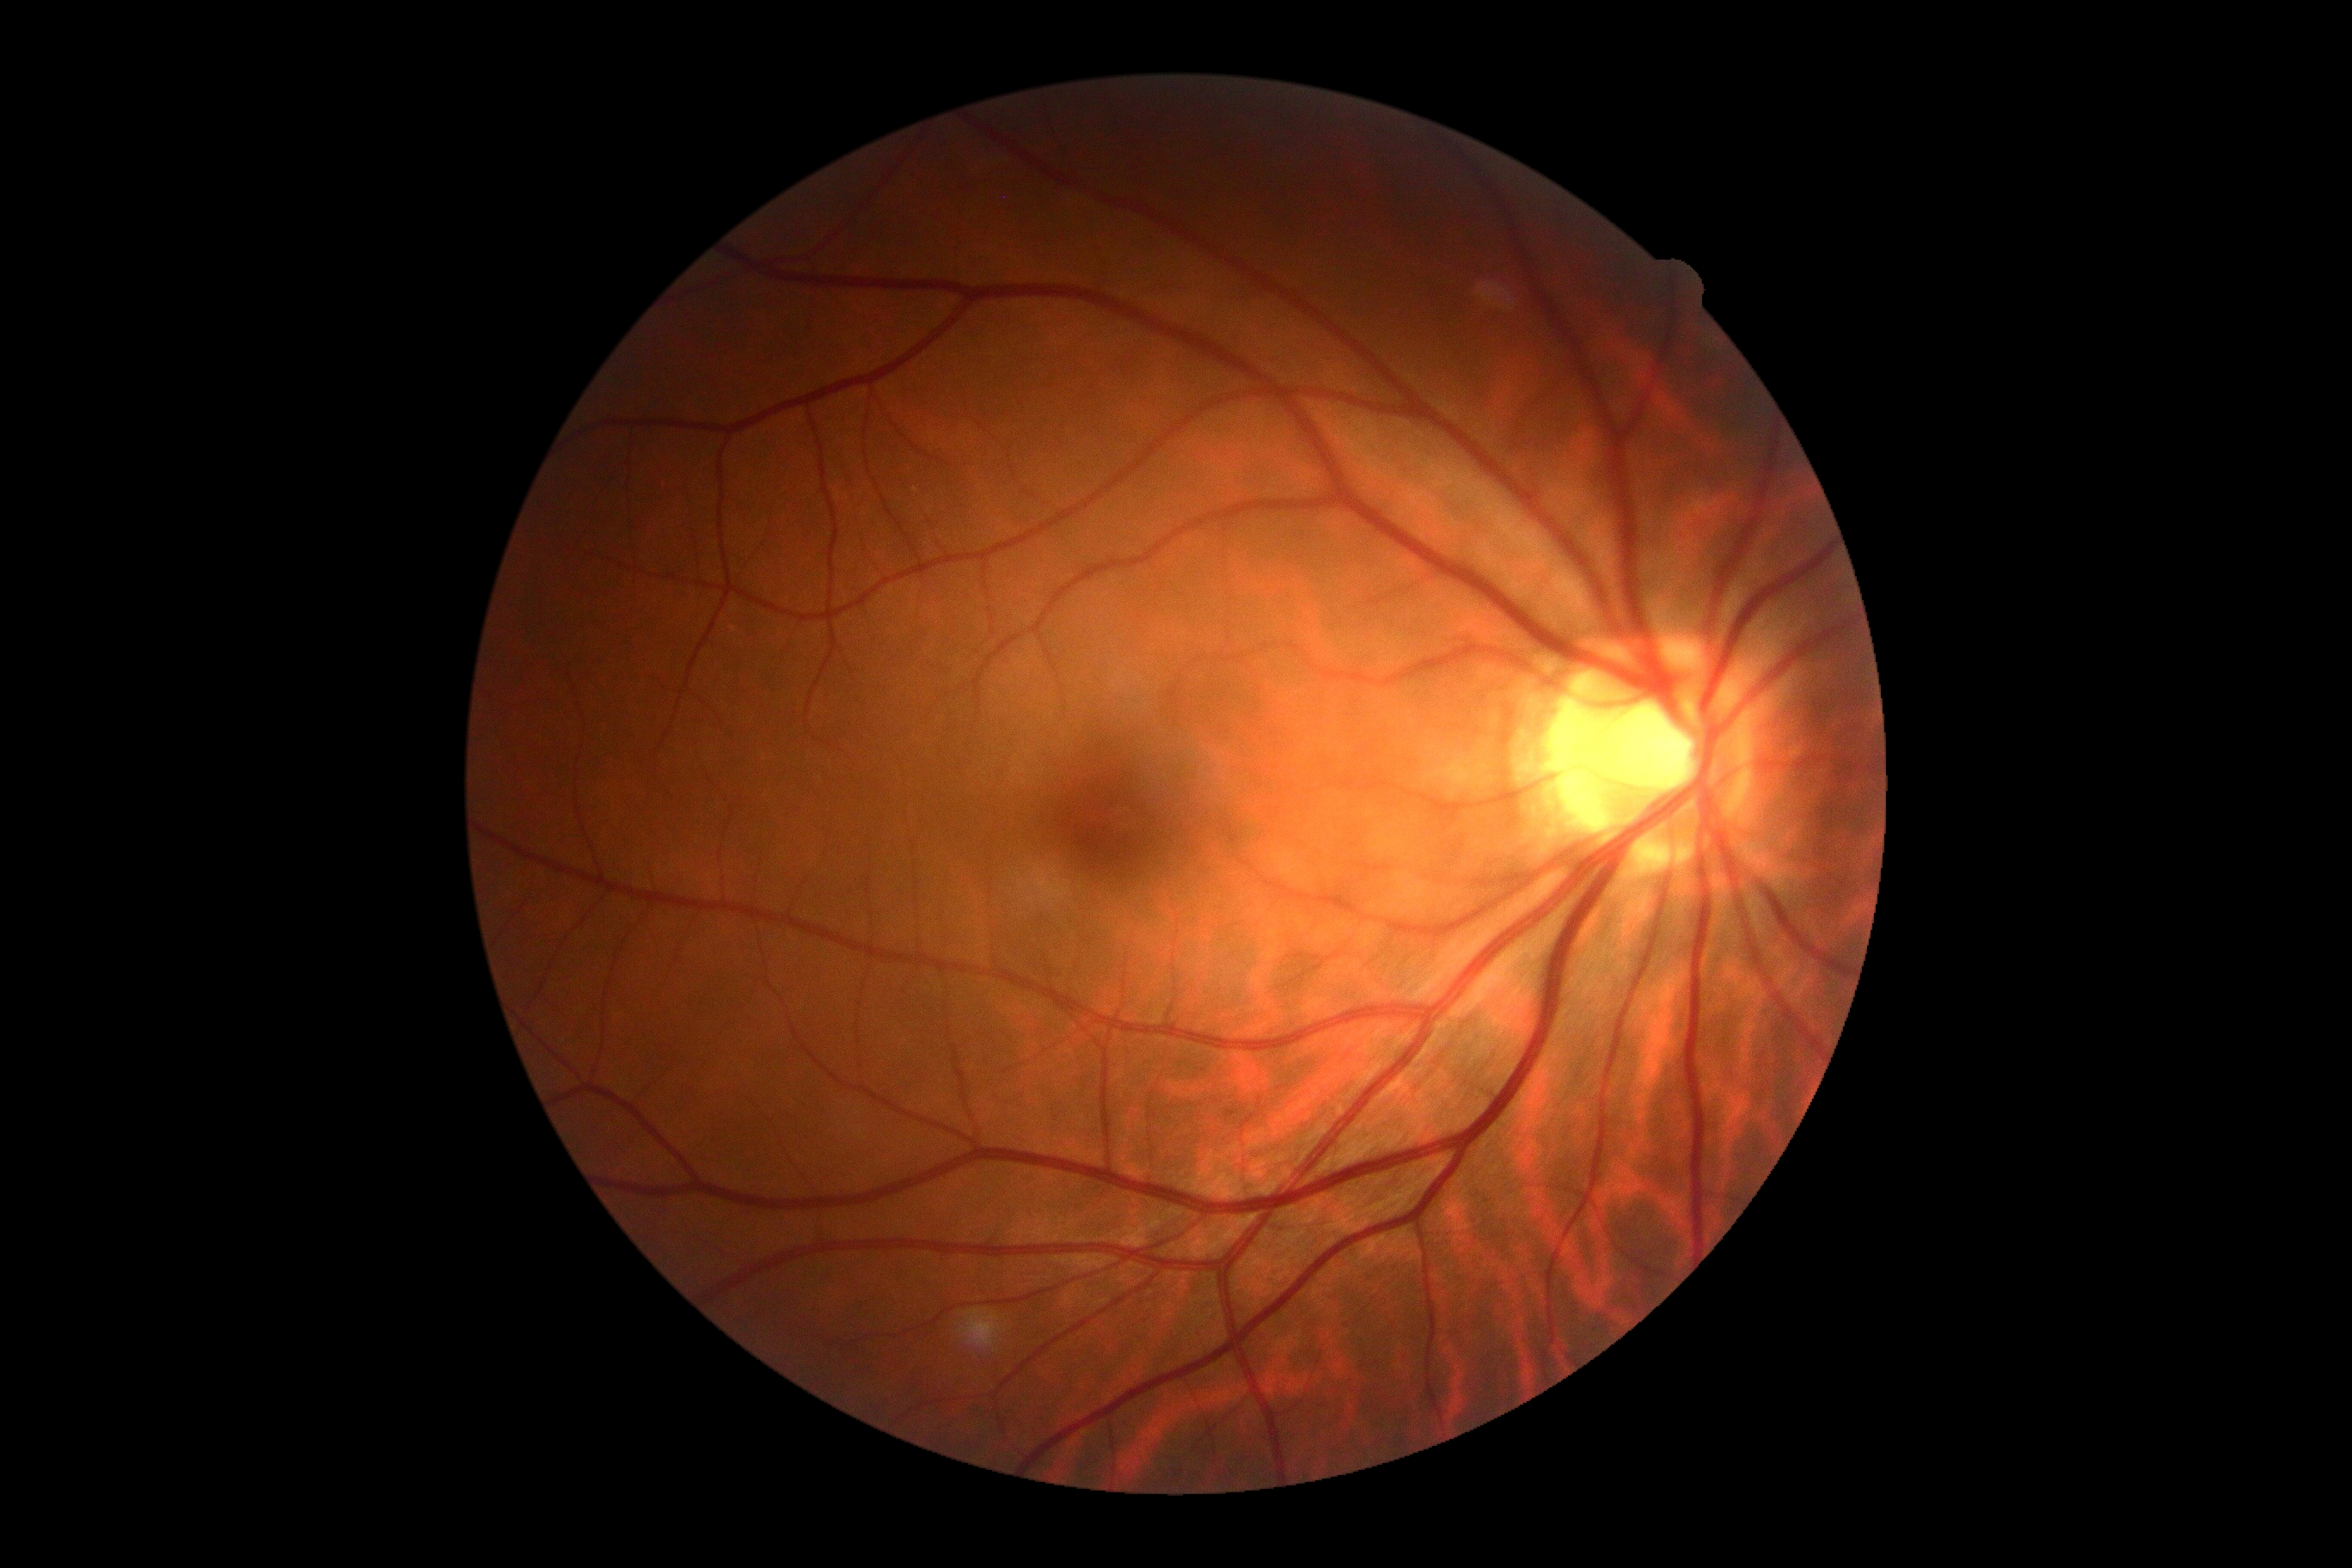 {"dr_grade": "grade 0", "dr_impression": "negative for DR"}